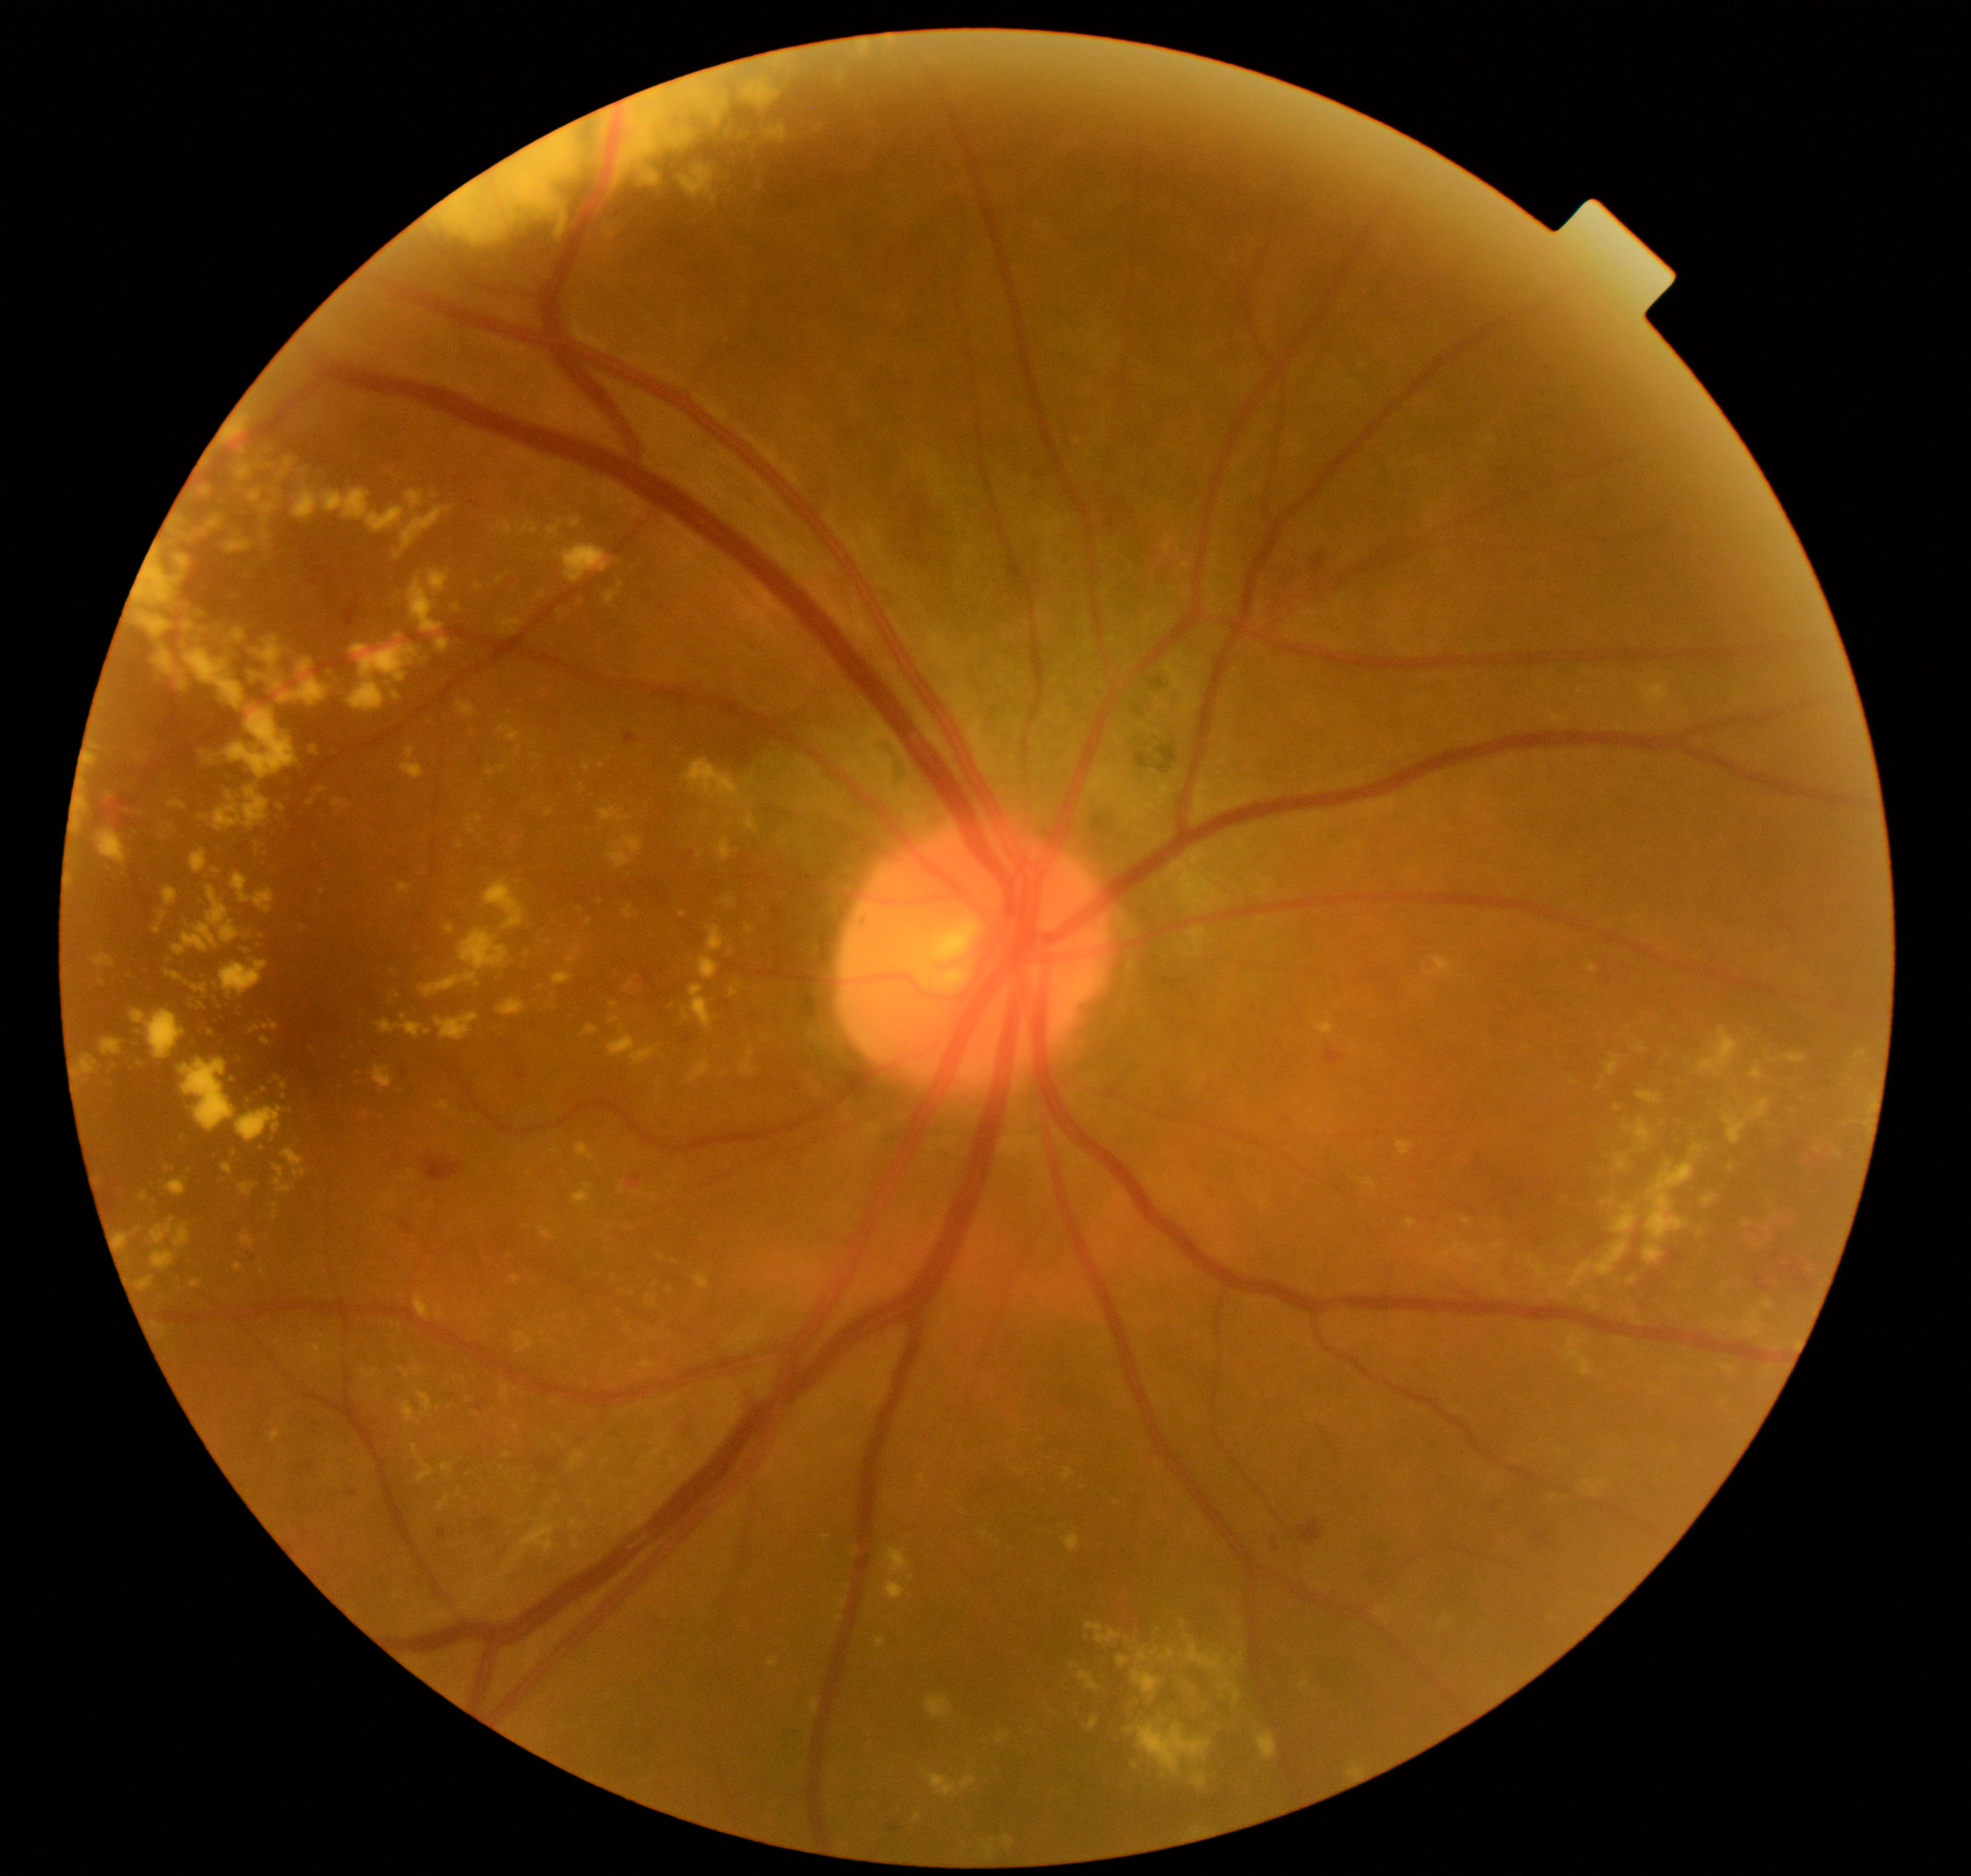 Primary finding: moderate non-proliferative diabetic retinopathy.